Non-mydriatic fundus camera. Captured on a Nidek AFC-330 fundus camera — 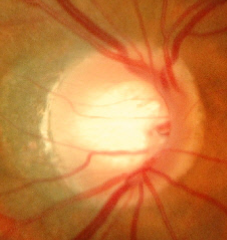

Optic disc appearance consistent with no signs of glaucoma.